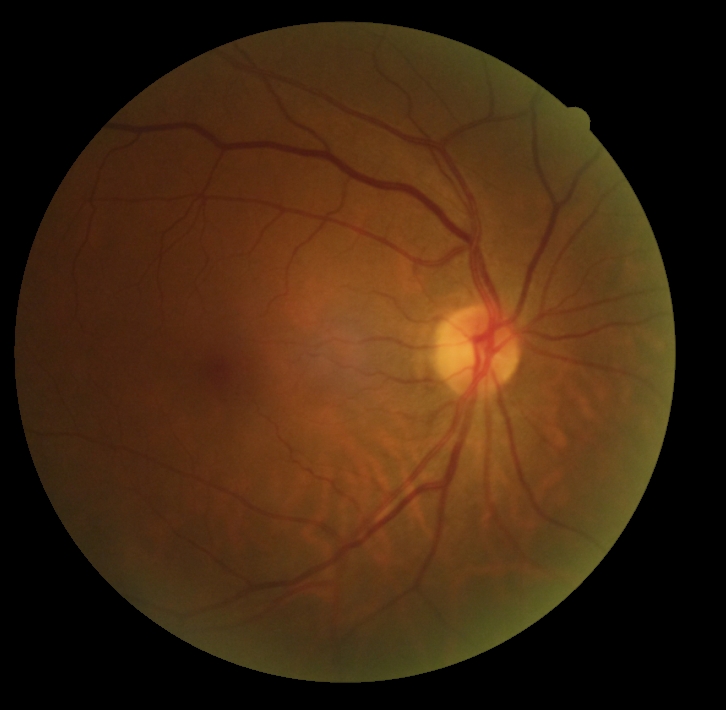
DR: 0 — no visible signs of diabetic retinopathy.